512x512:
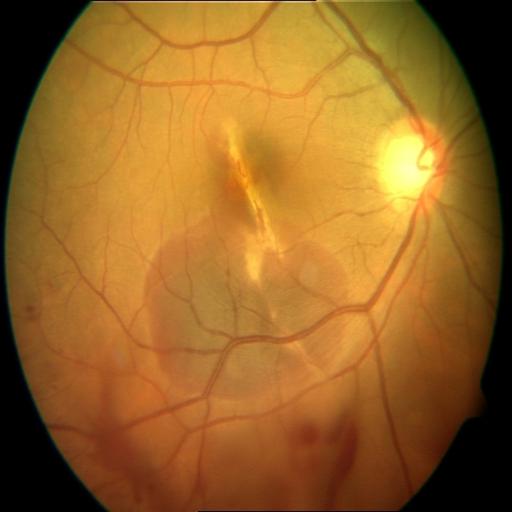 Pathology:
- chorioretinitis
- choroidal folds
- hemorrhagic retinopathy